Color fundus photograph. 240 x 240 pixels. Optic disc region crop
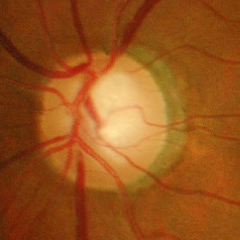 Demonstrates advanced glaucomatous optic neuropathy.